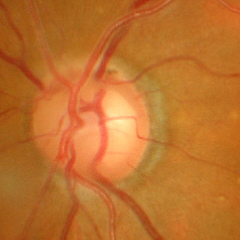

Q: What stage of glaucoma is present?
A: Advanced glaucomatous optic neuropathy.